640x480. Wide-field fundus photograph of an infant — 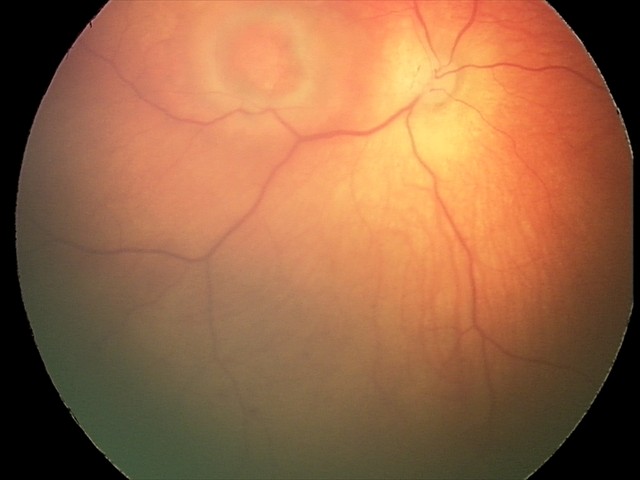 Screening series with toxoplasmosis chorioretinitis.